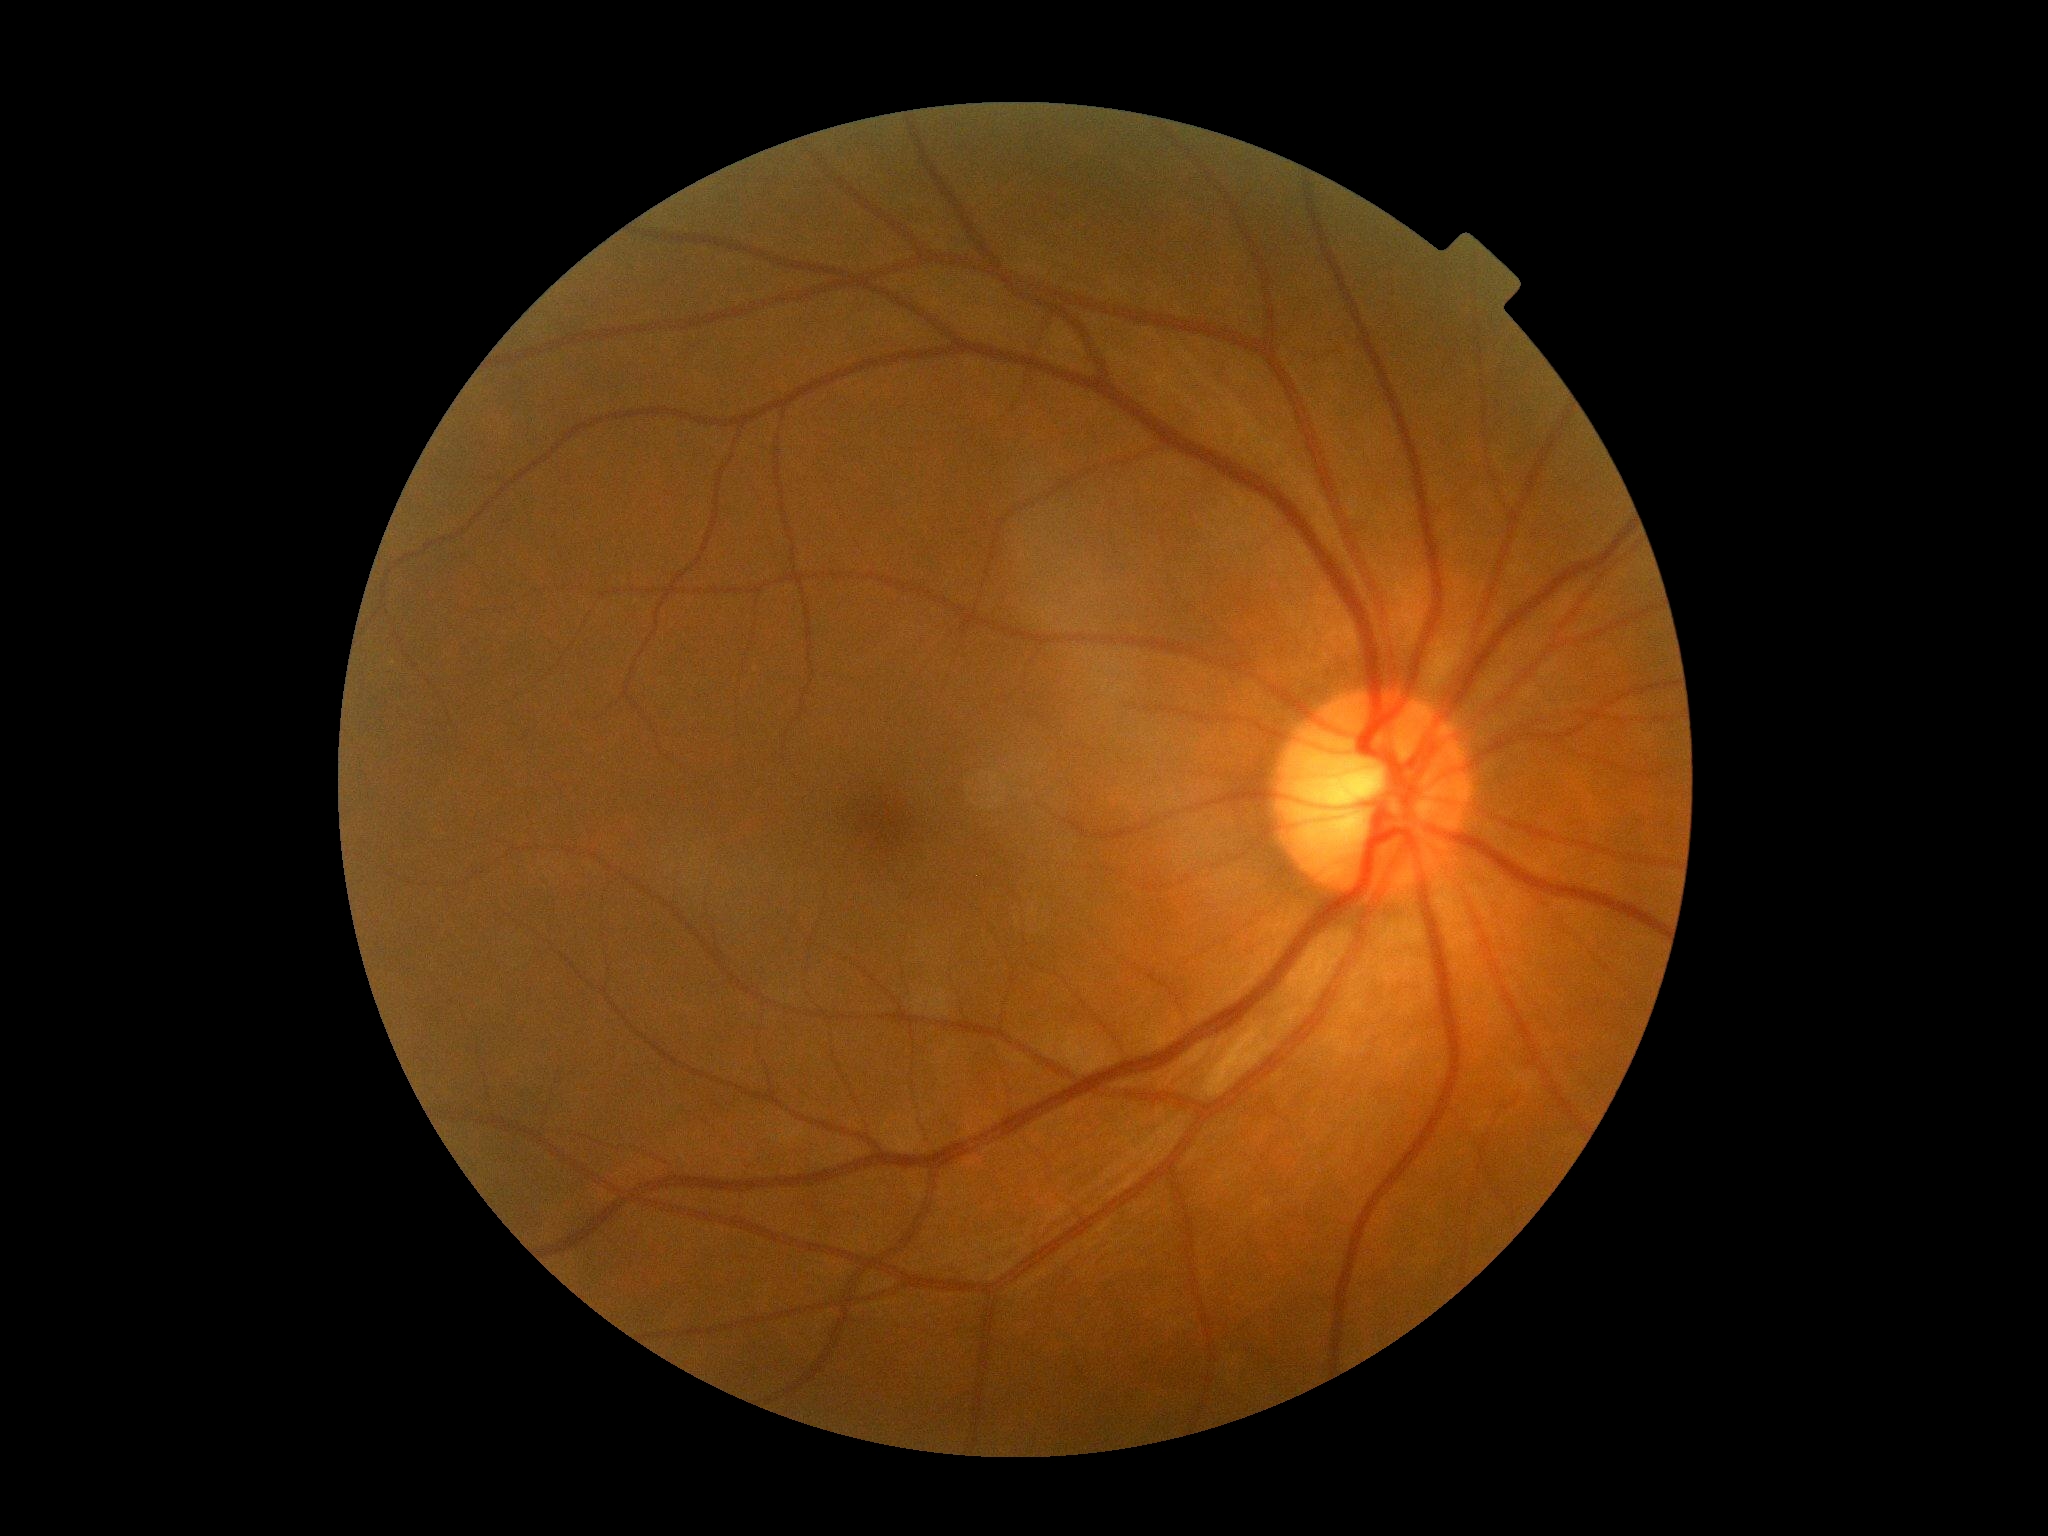

DR severity: 0.
No DR findings.